Wide-field fundus image from infant ROP screening
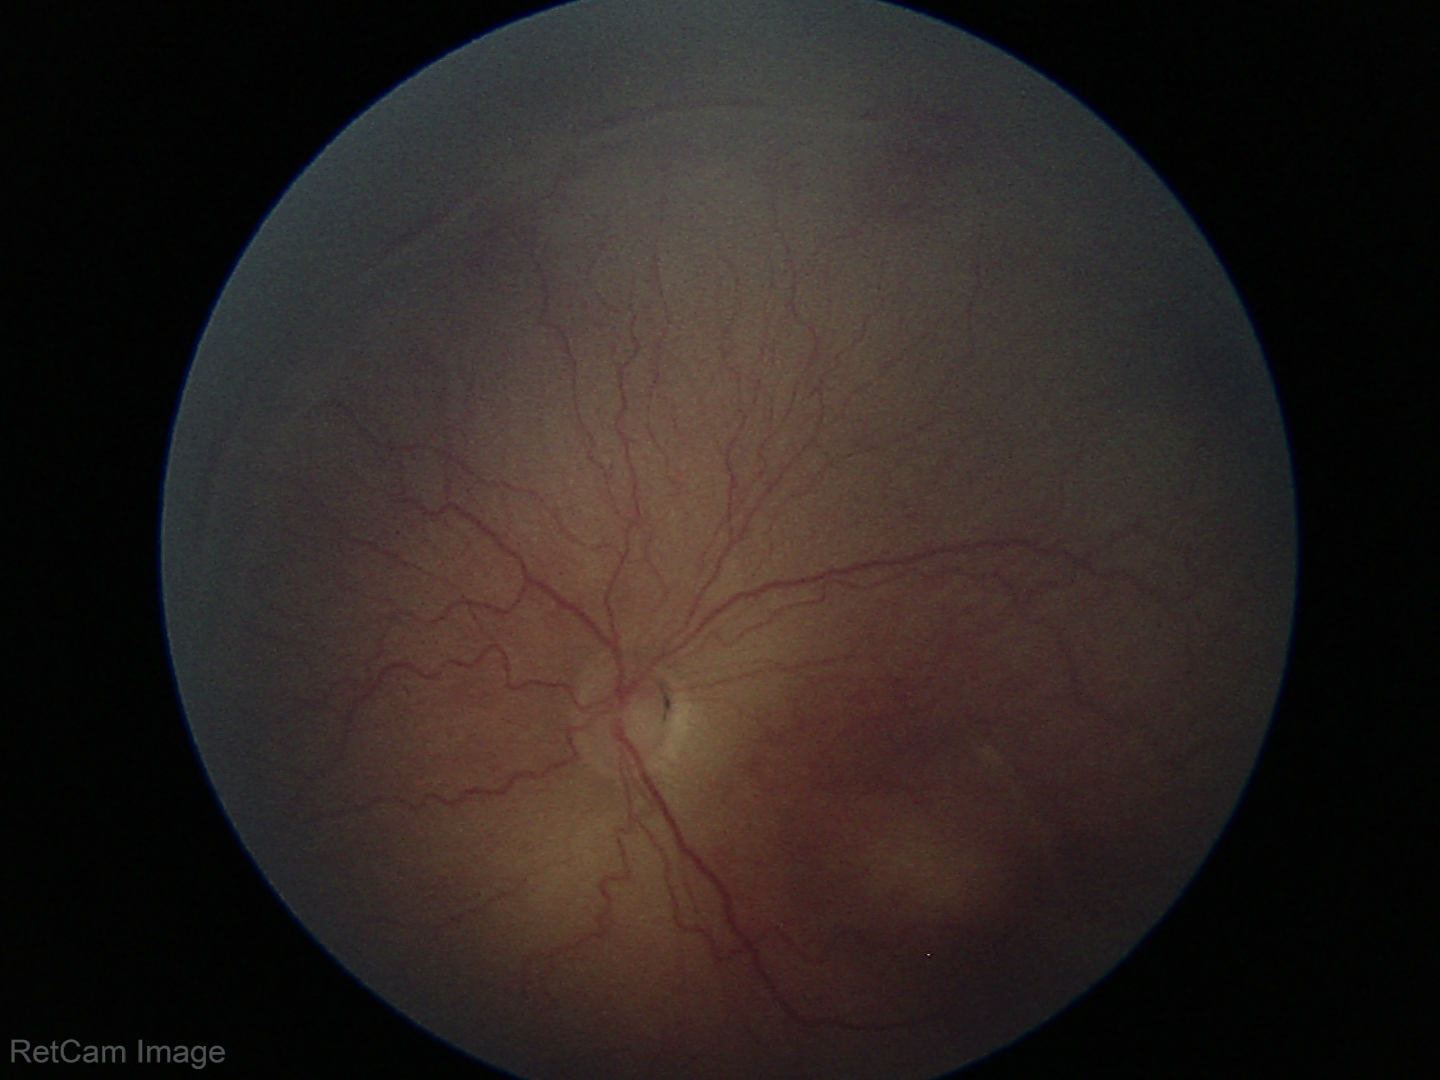
No plus disease. Examination diagnosed as retinopathy of prematurity (ROP) stage 2.